Pediatric retinal photograph (wide-field) · 640x480px
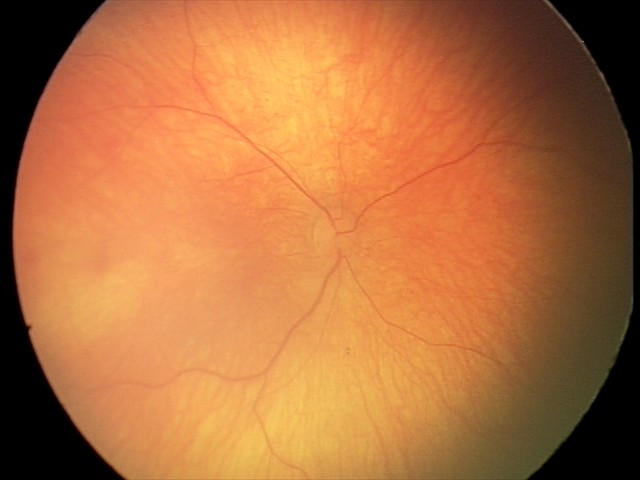

Screening: normal retinal appearance.